Optic nerve head crop. 240x240
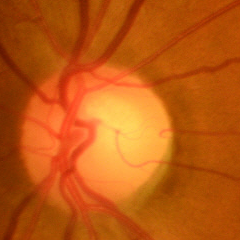
Showing no glaucomatous changes.